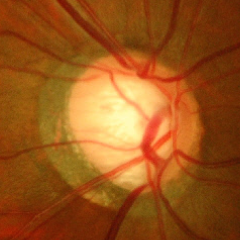
Advanced glaucoma.